848 by 848 pixels.
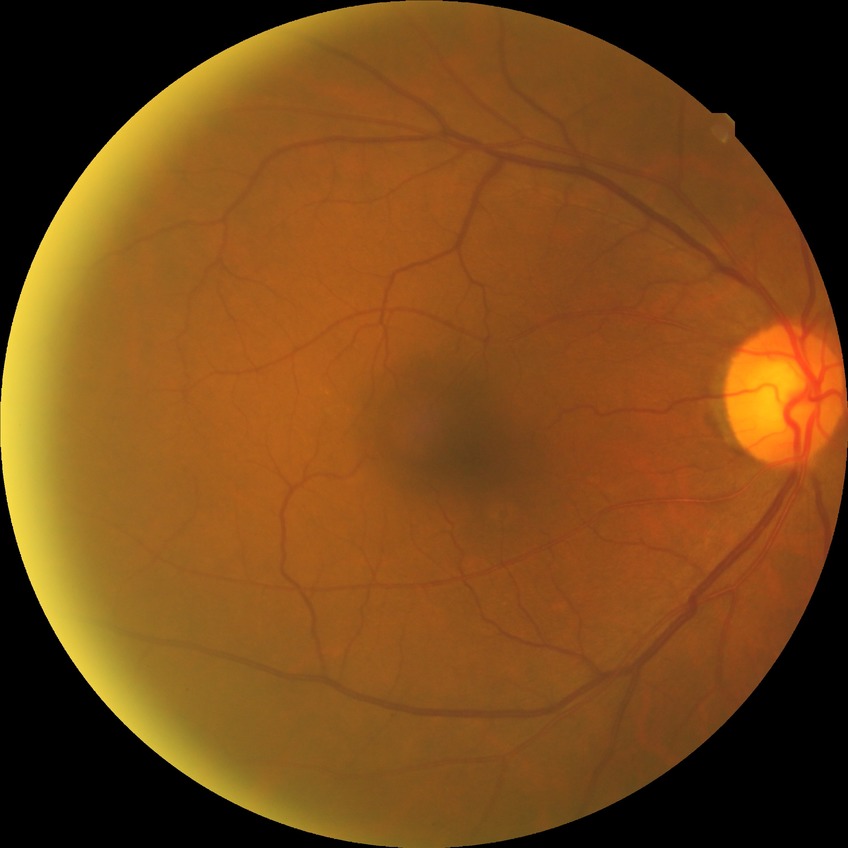

Diabetic retinopathy (DR): NDR (no diabetic retinopathy).